2212 x 1659 pixels
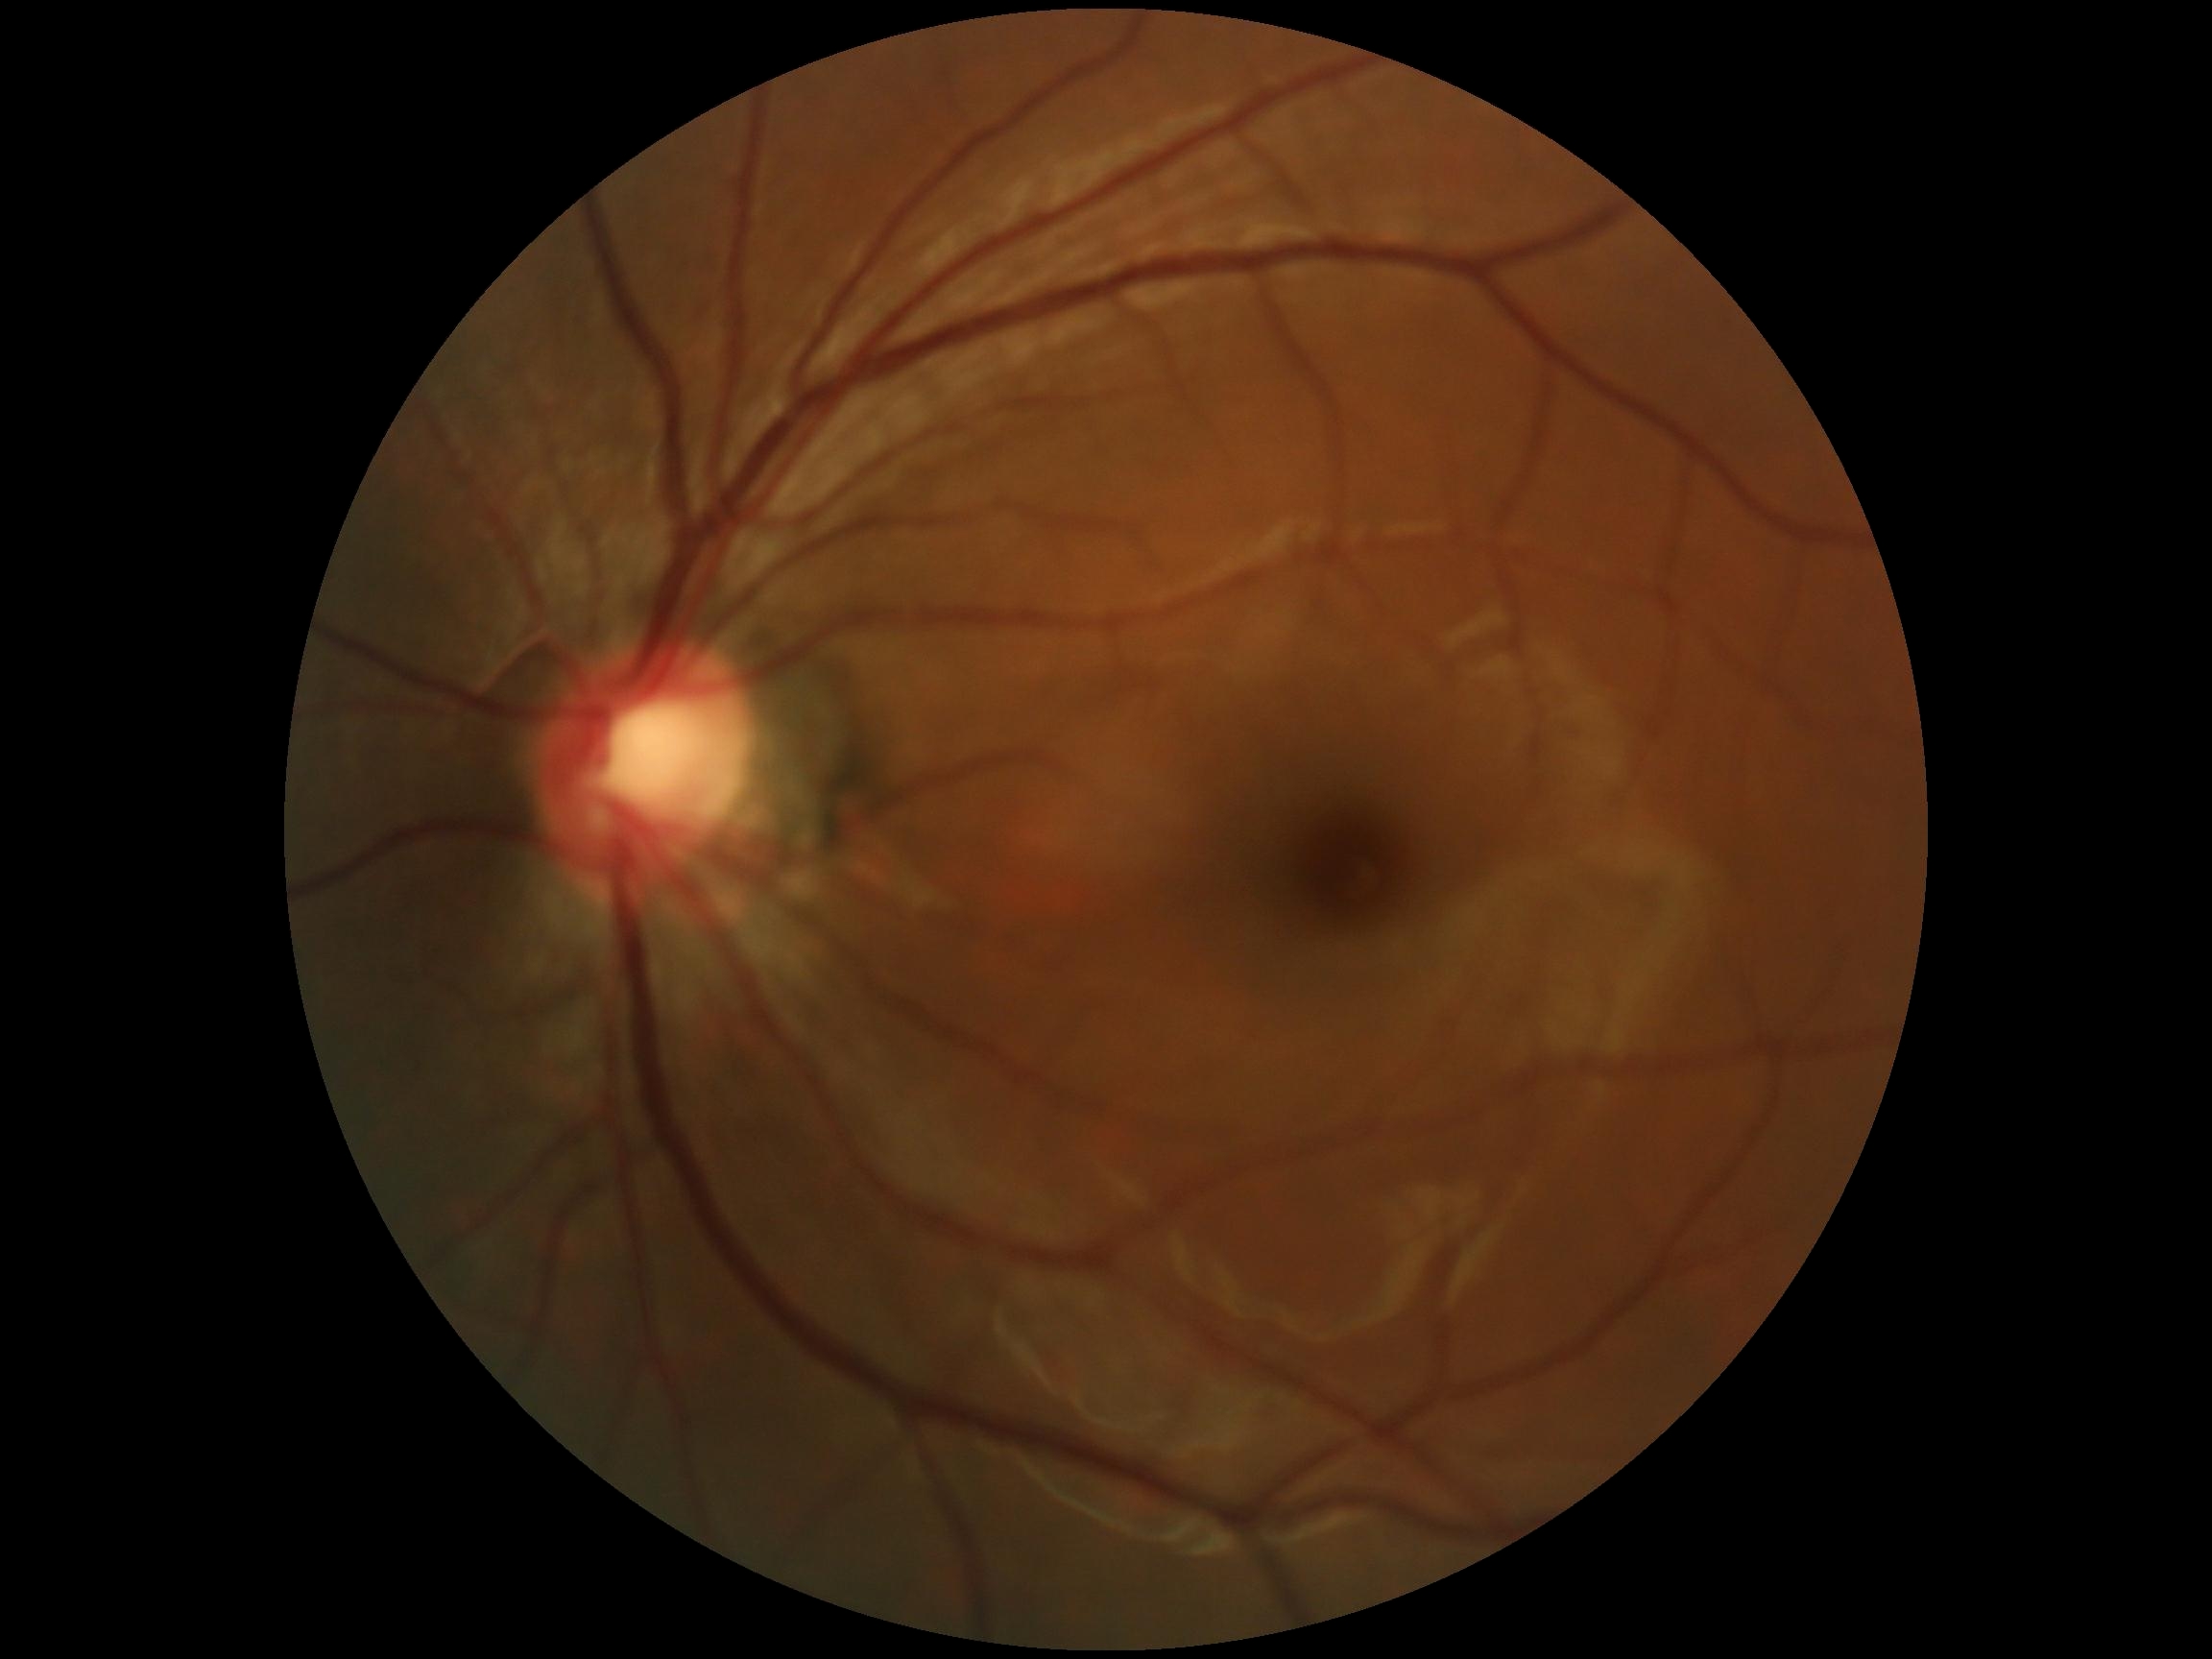
Diabetic retinopathy (DR) is grade 0 (no apparent retinopathy).